Camera: NIDEK AFC-230, 848 by 848 pixels.
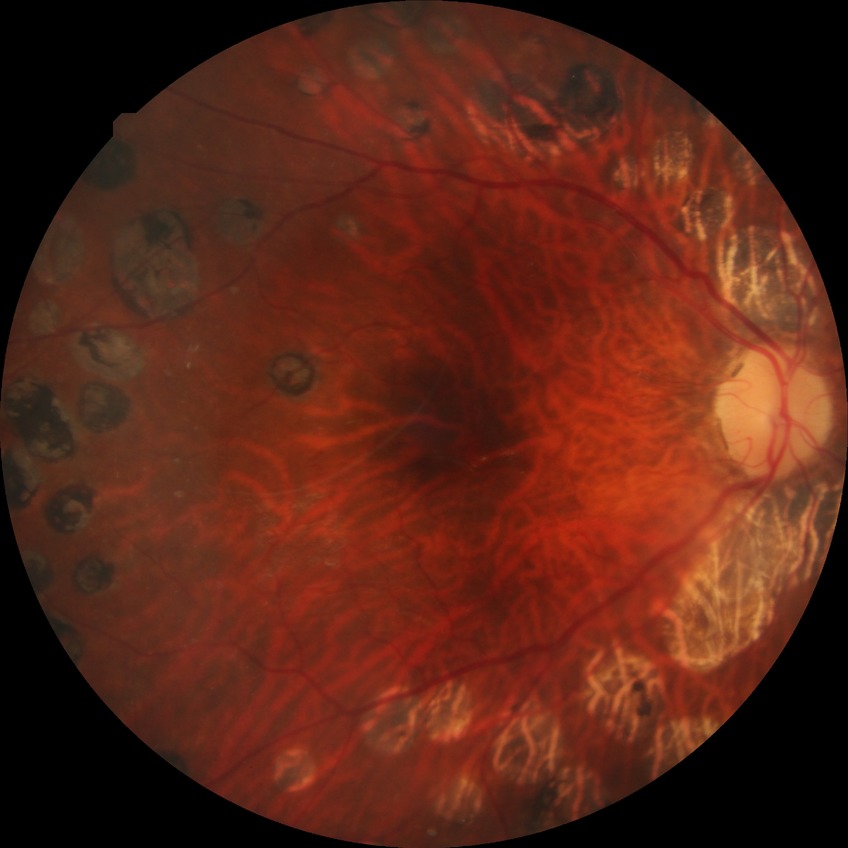 diabetic retinopathy (DR)=PDR (proliferative diabetic retinopathy).